Color fundus image: 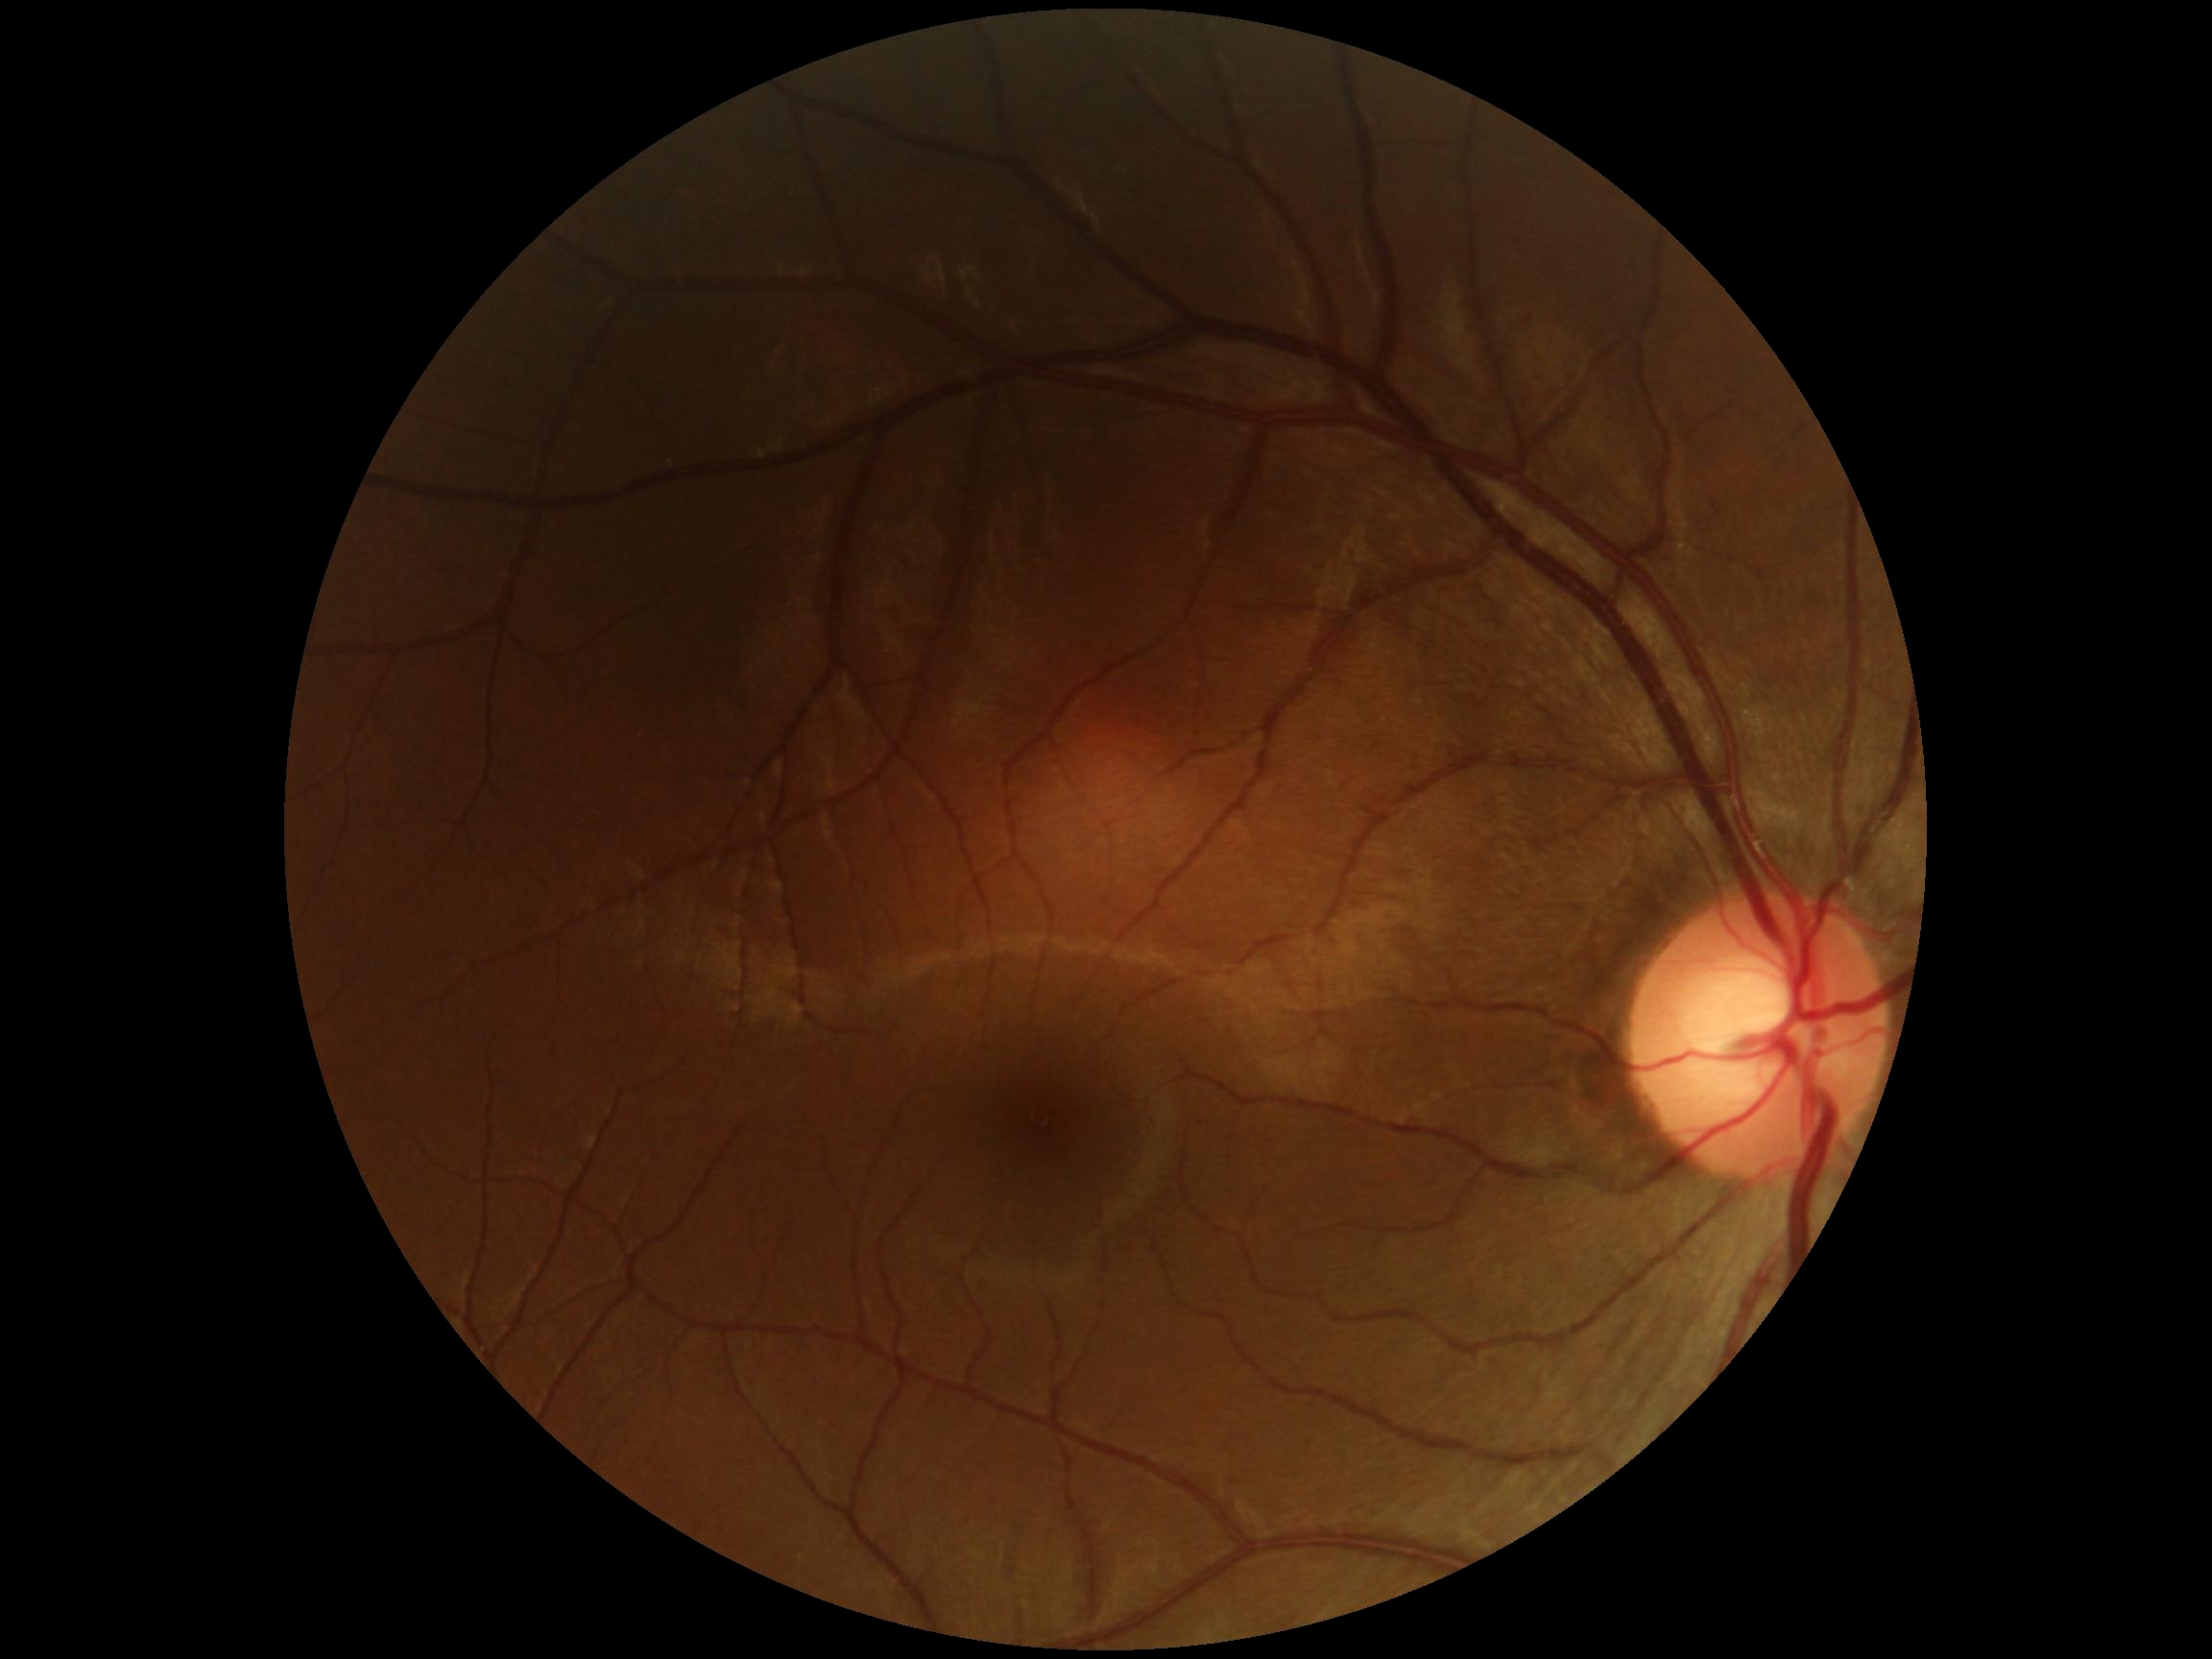

  dr_impression: no apparent DR
  dr_grade: no apparent diabetic retinopathy (0)